848x848 · modified Davis classification · posterior pole color fundus photograph.
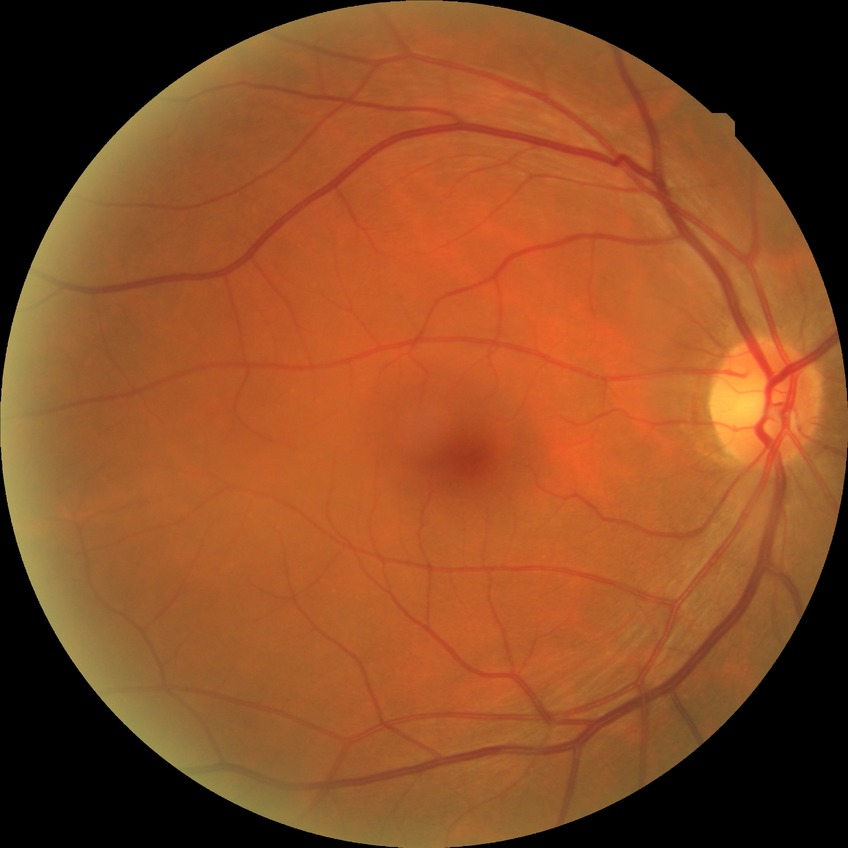
Modified Davis grading is no diabetic retinopathy.